Acquired on the Clarity RetCam 3 · 640 by 480 pixels · infant wide-field fundus photograph: 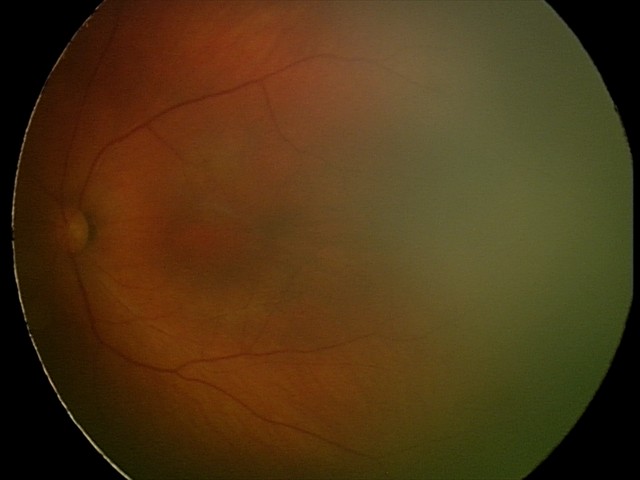
Examination with physiological retinal findings.